Retinal fundus photograph. Image size 848x848. FOV: 45 degrees.
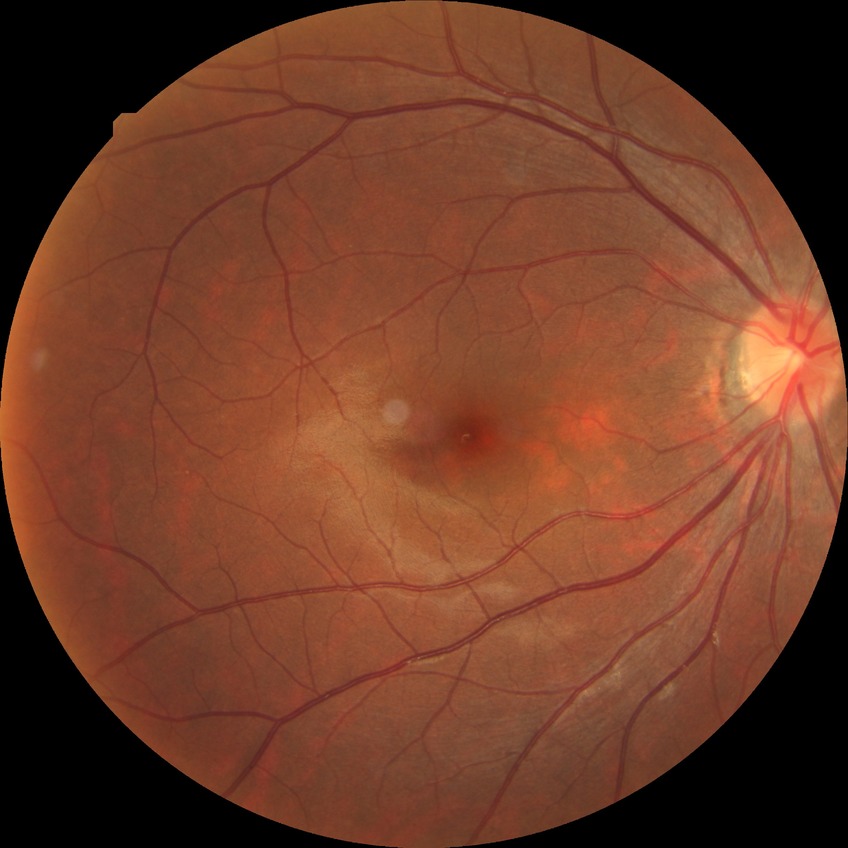 Modified Davis classification: no diabetic retinopathy.